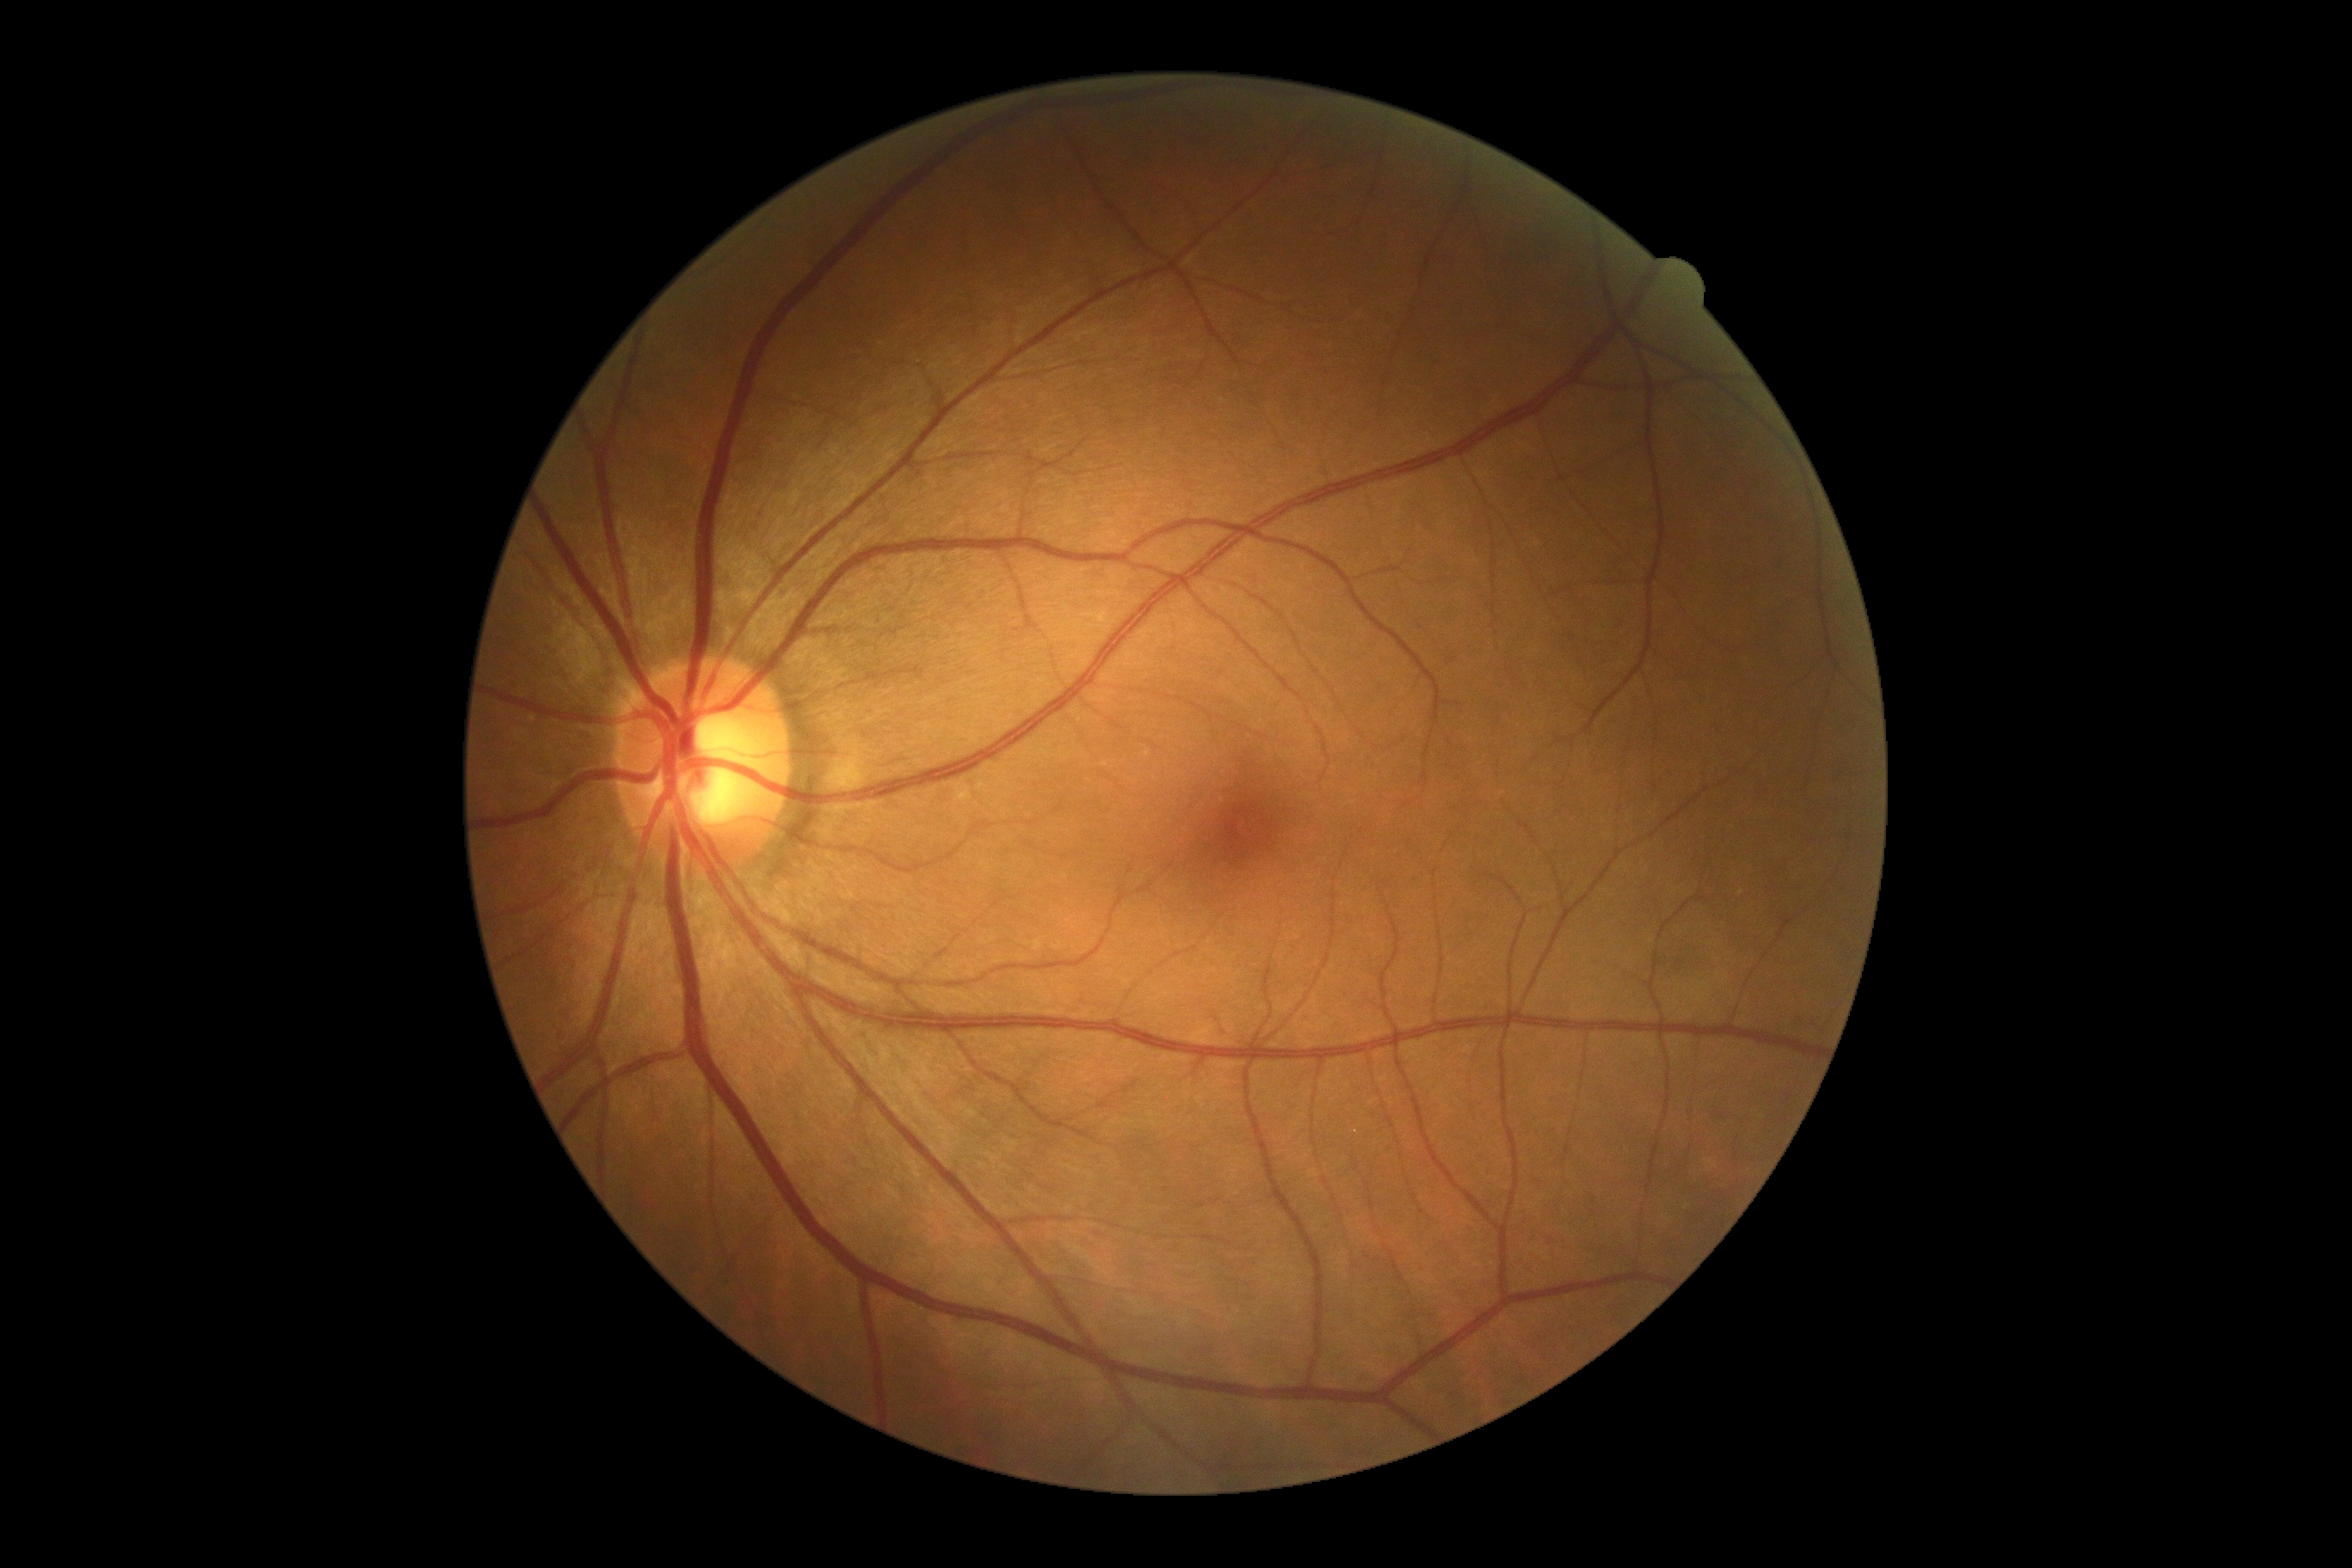 Annotations:
• DR stage — grade 0 (no apparent retinopathy)